2361 by 1568 pixels. Camera: Kowa VX-10α
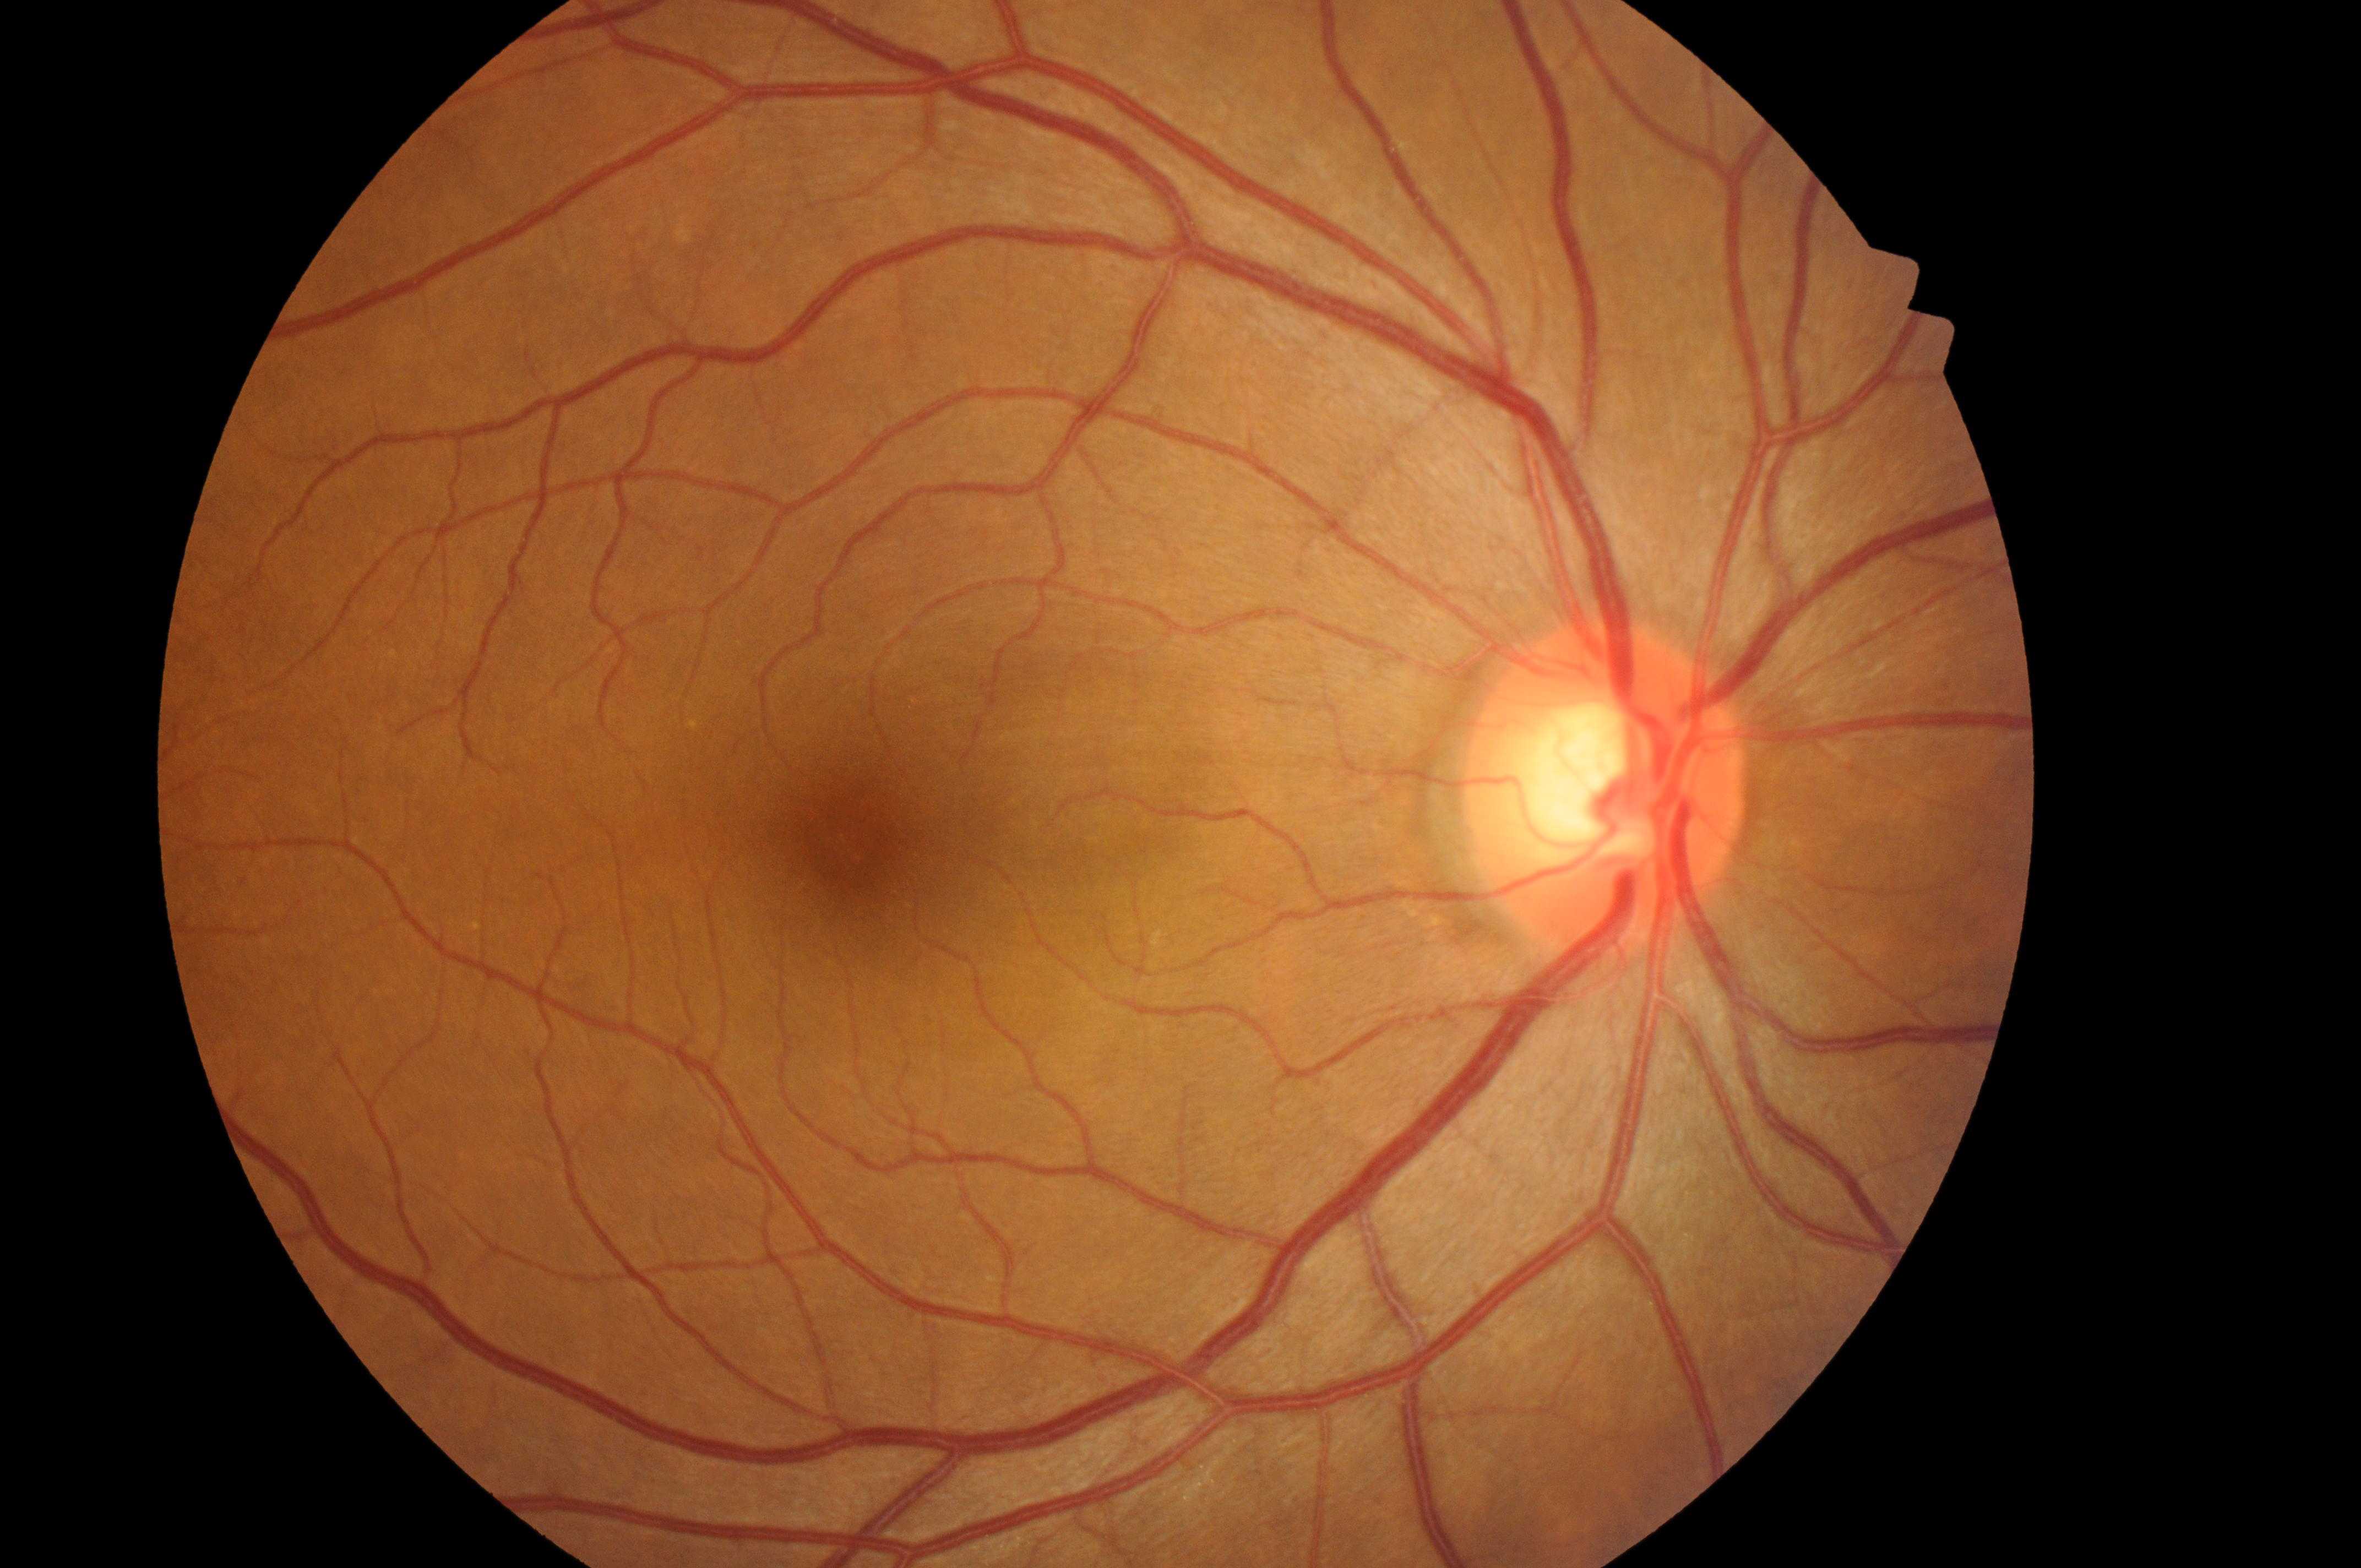 Diabetic retinopathy grade is 0/4 — no visible signs of diabetic retinopathy. Optic disc located at (1605, 804). Fovea centralis located at (847, 841). No signs of diabetic retinopathy or diabetic macular edema. Risk of macular edema is 0/2 — no apparent hard exudates. The image shows the right eye.